Infant wide-field retinal image
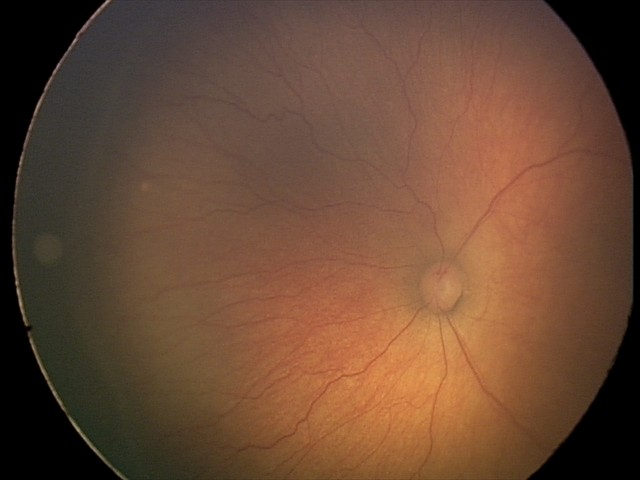

Assessment = retinopathy of prematurity stage 2
plus disease = absent